Retinal fundus photograph: 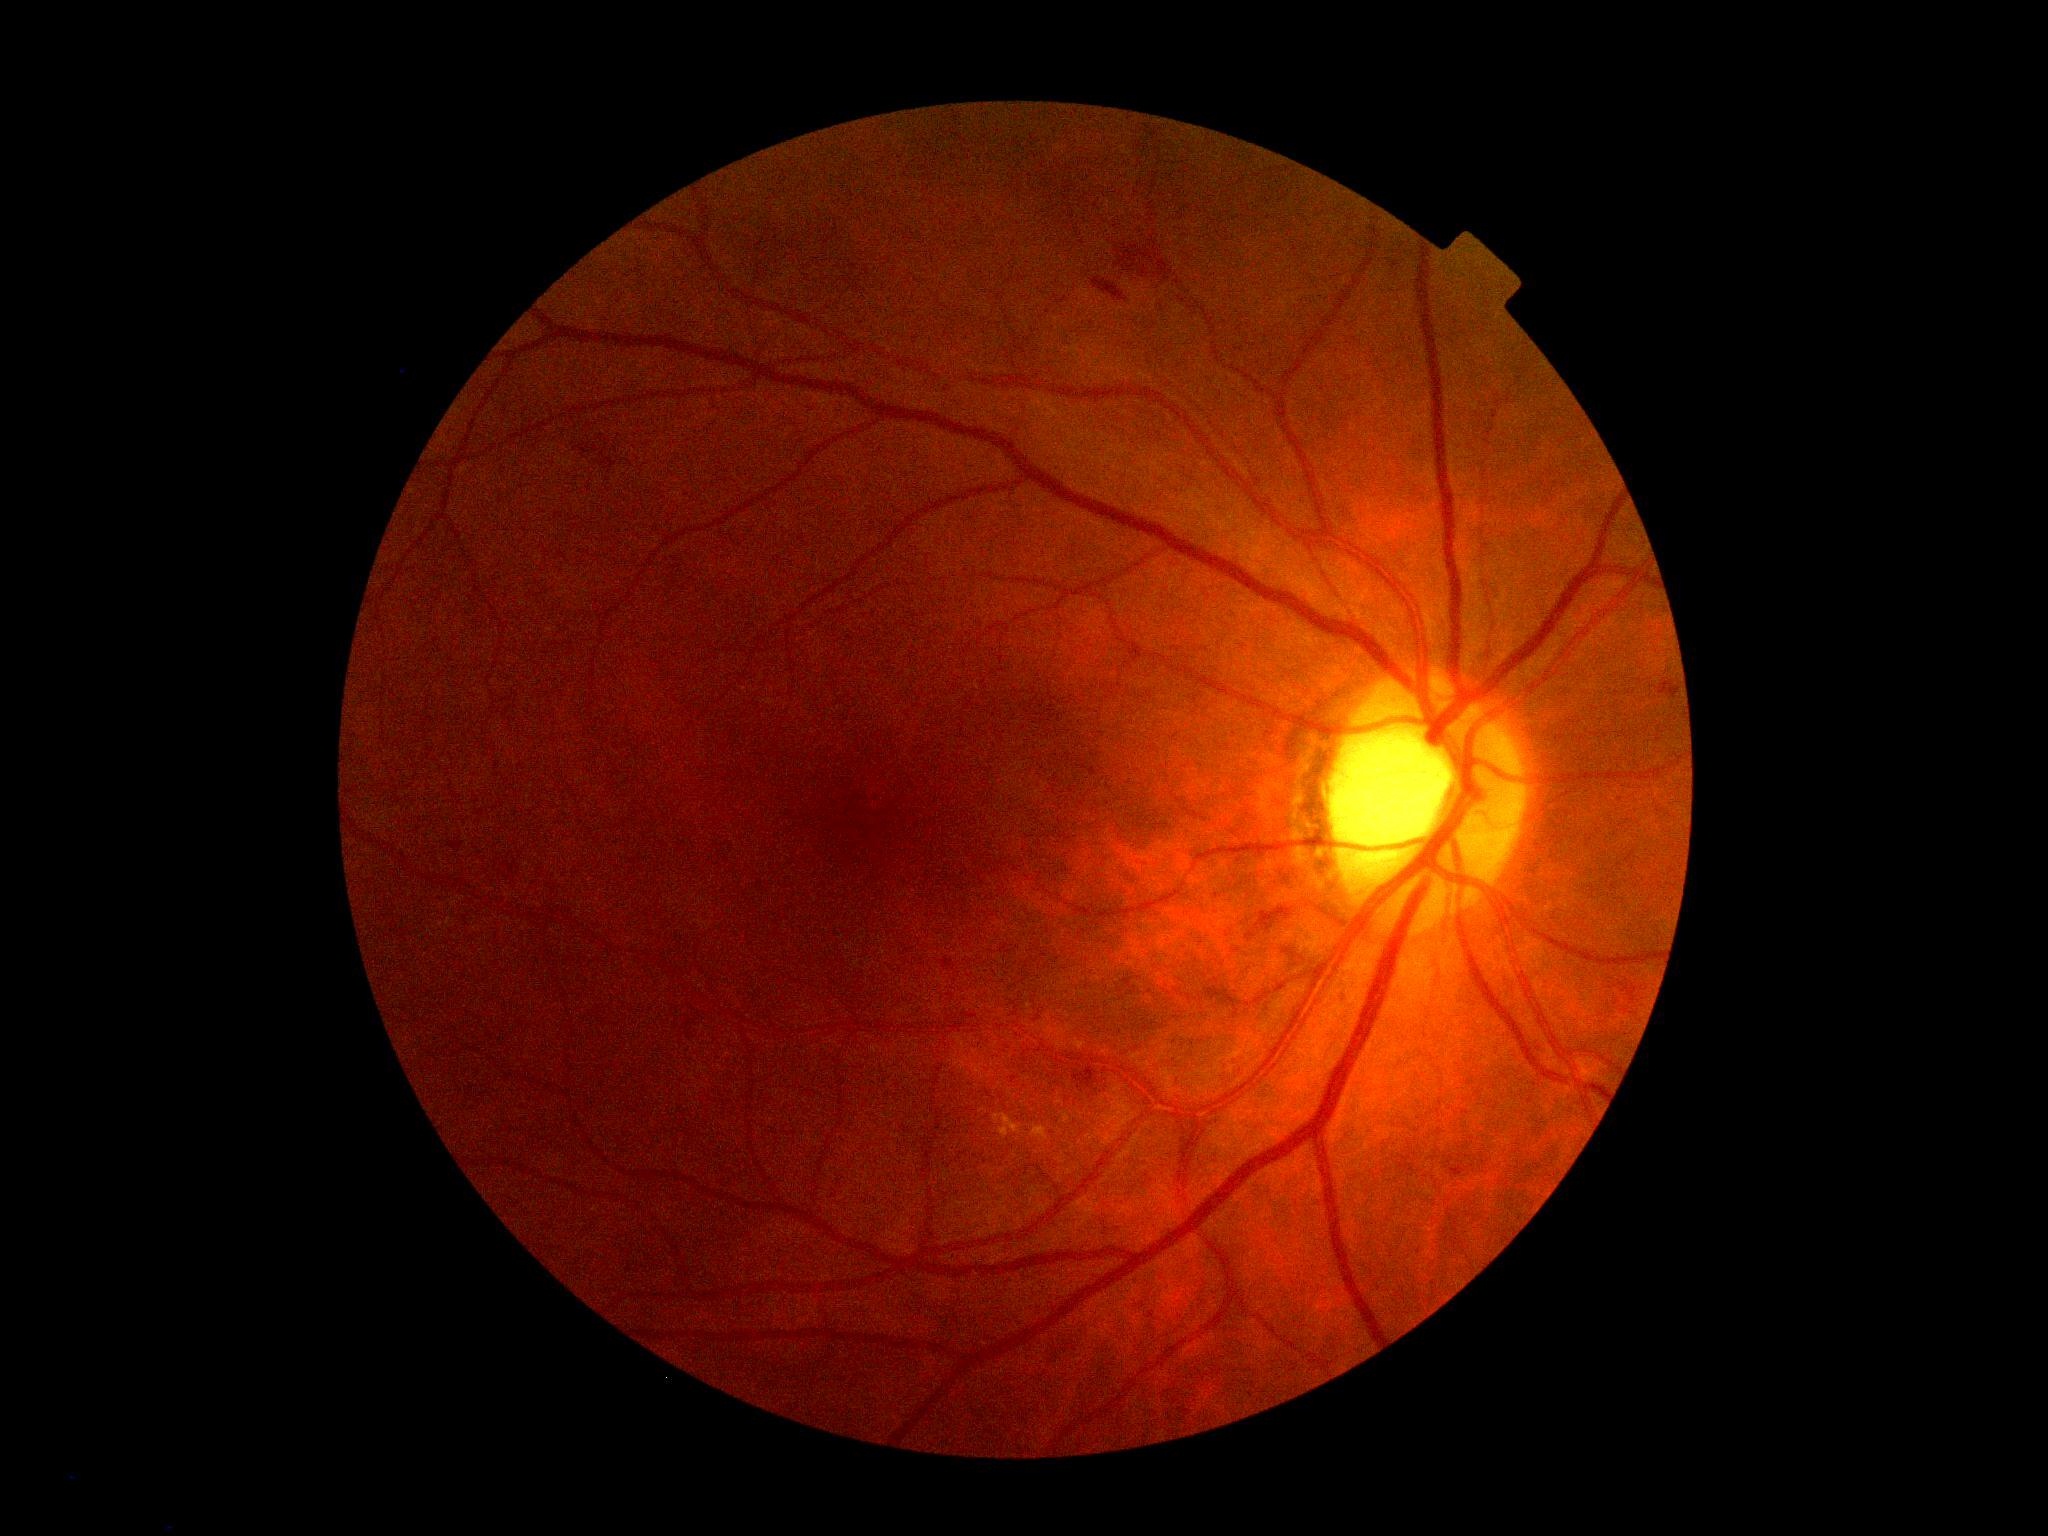
retinopathy grade@2 (moderate NPDR).